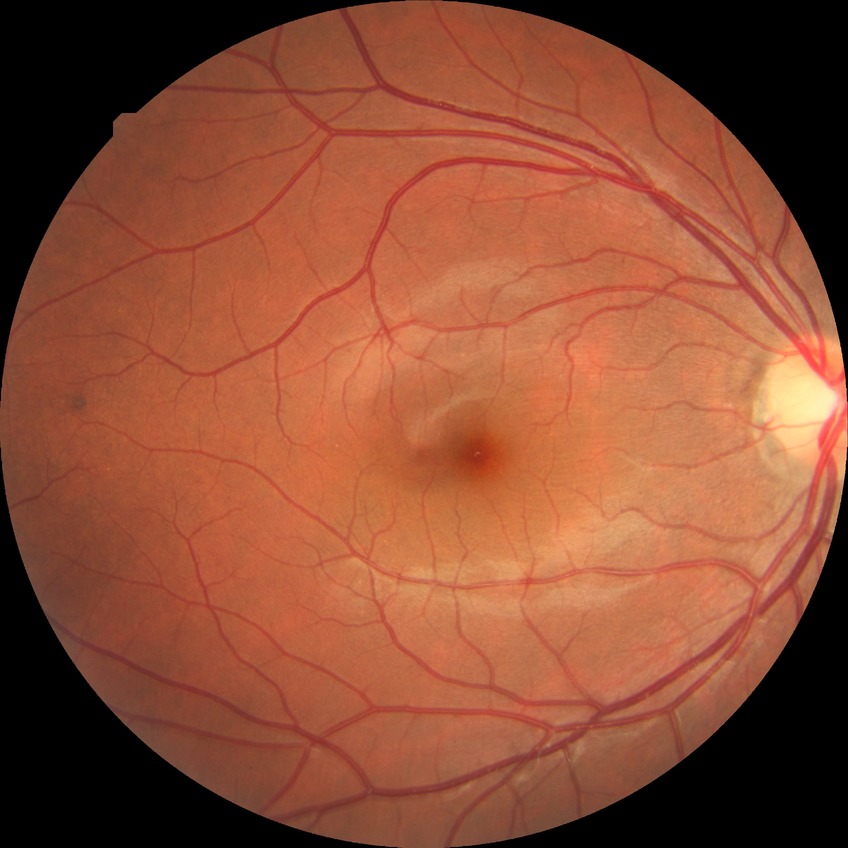
Diabetic retinopathy grade: no diabetic retinopathy.